Color fundus photograph — 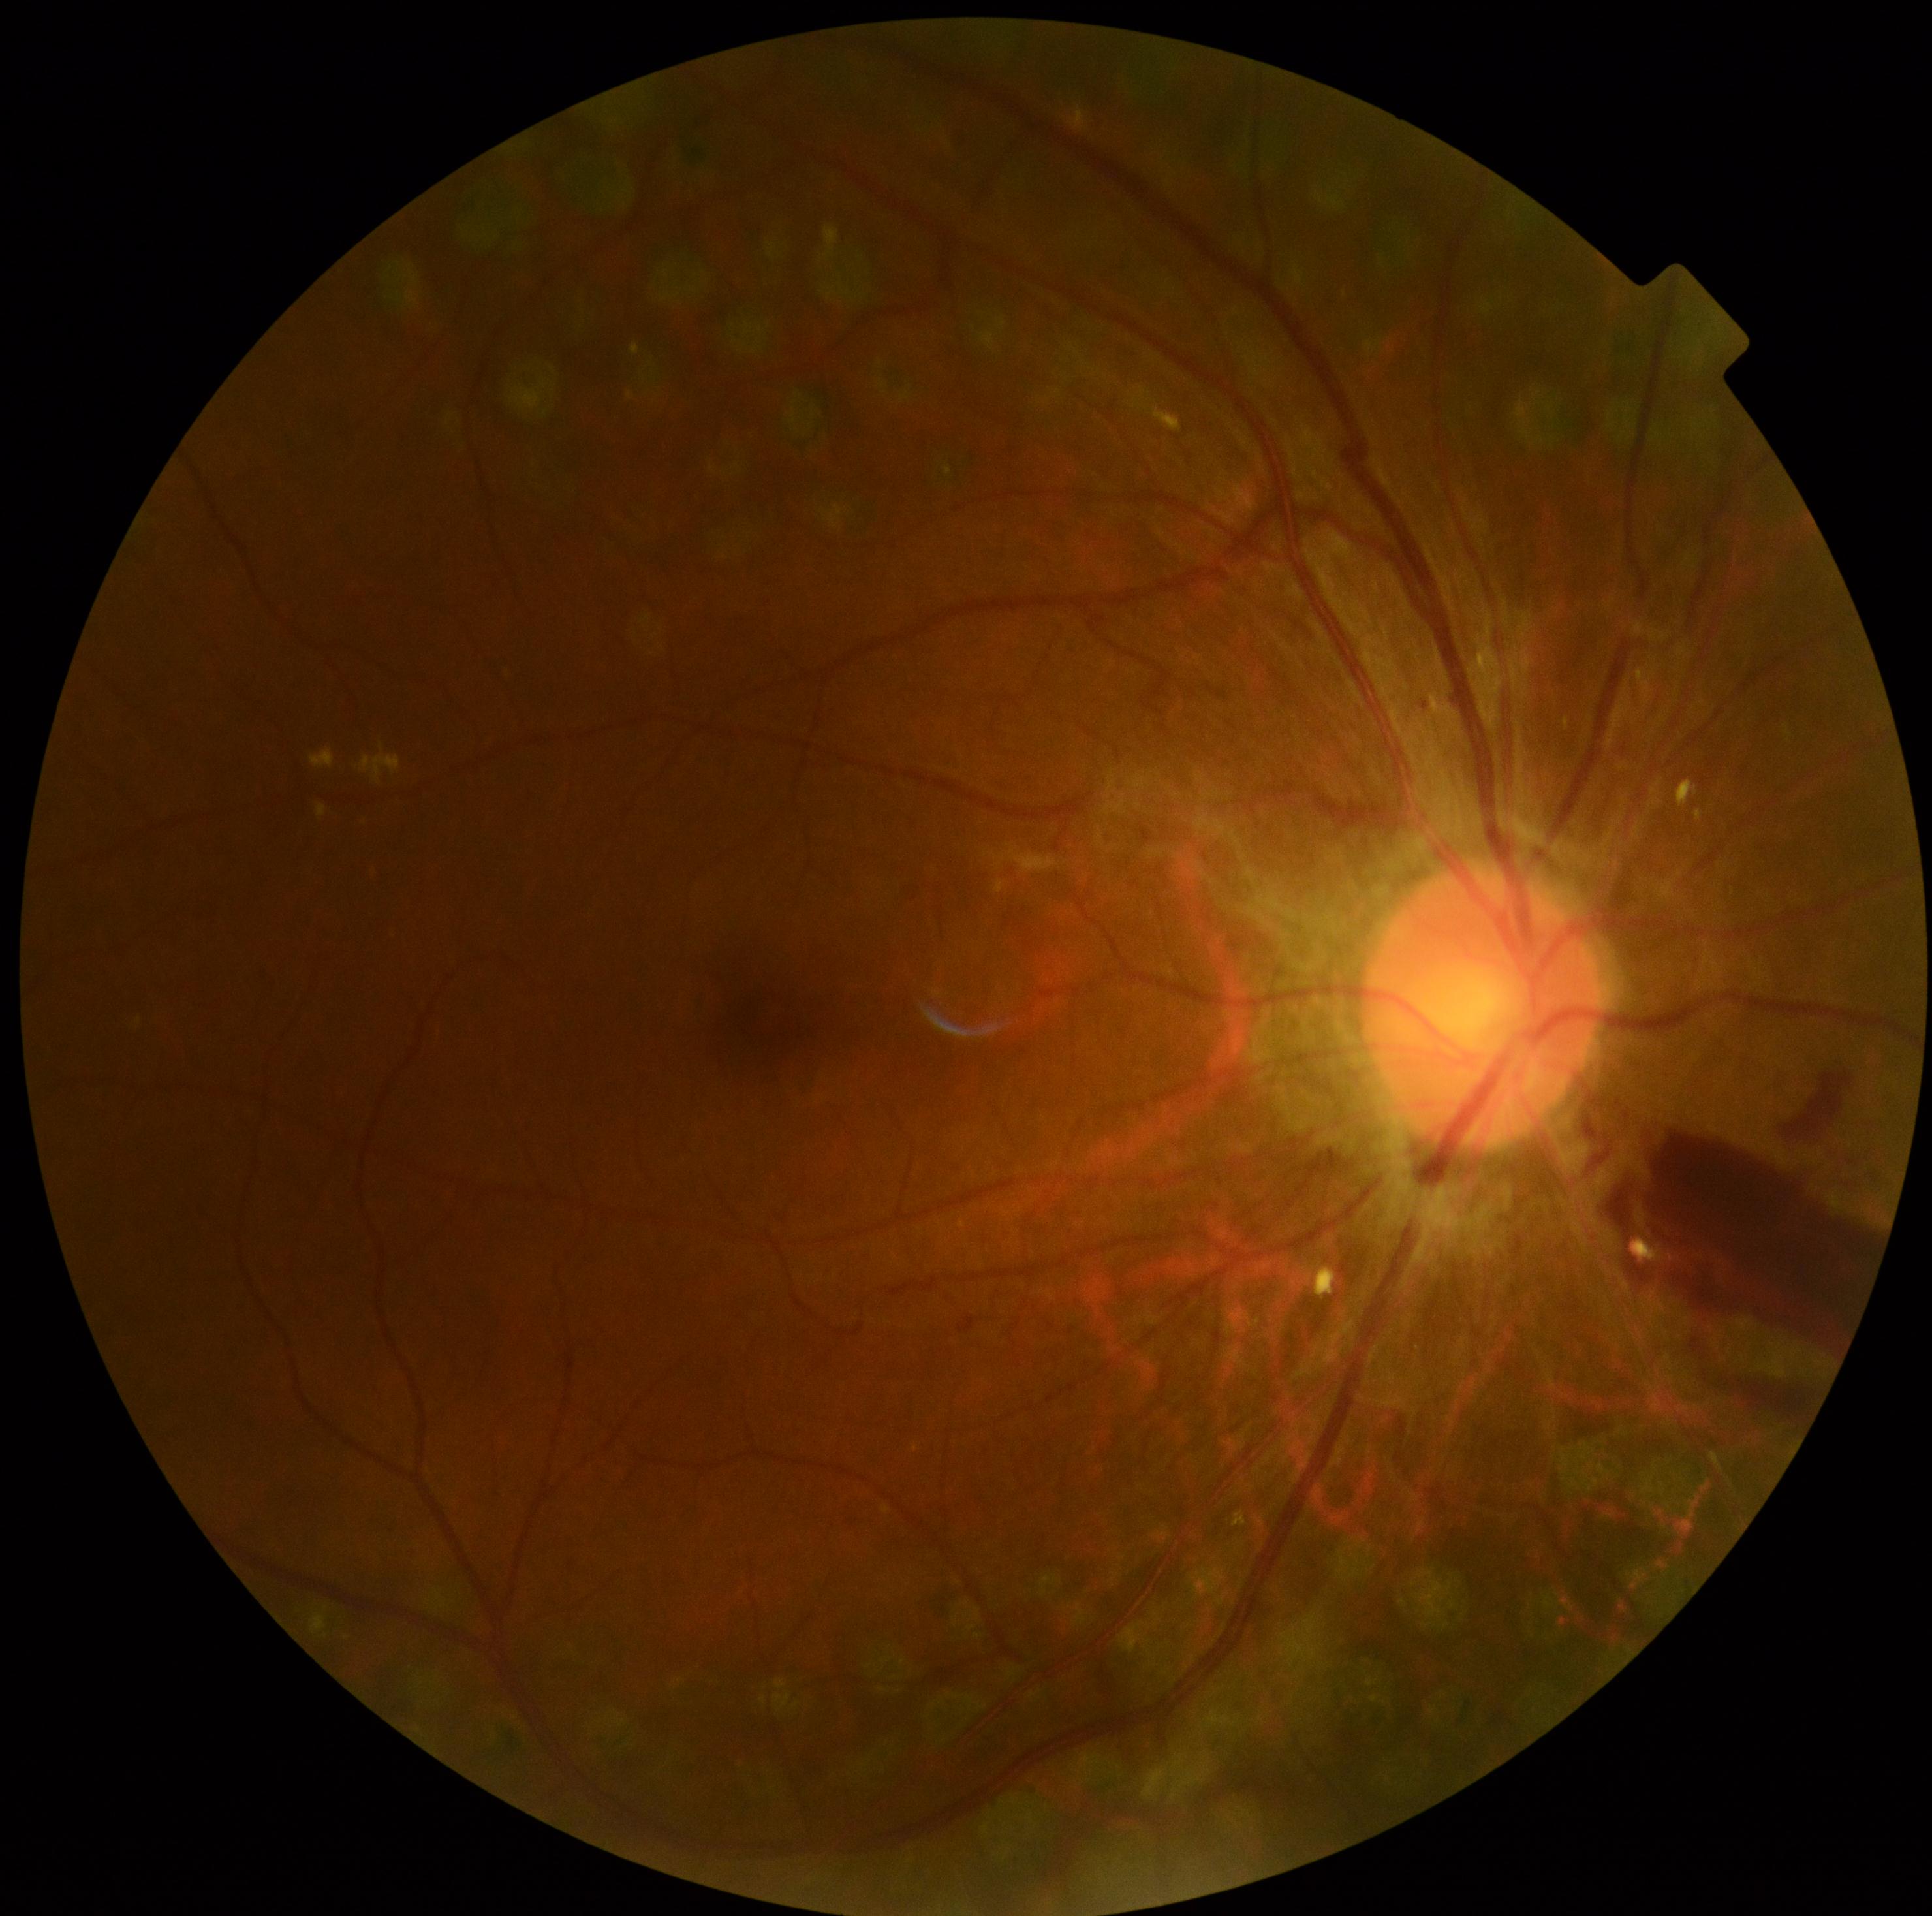

The retinopathy is classified as proliferative diabetic retinopathy. DR is 4/4.